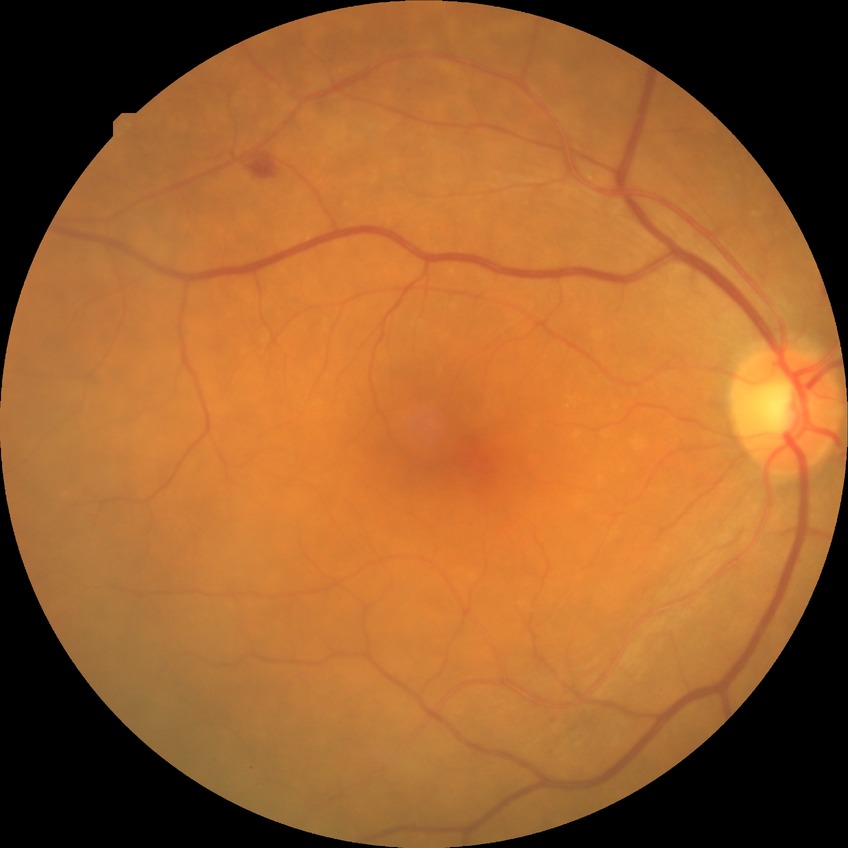

diabetic retinopathy grade = simple diabetic retinopathy.